RetCam wide-field infant fundus image · camera: Clarity RetCam 3 (130° FOV) · 640x480px:
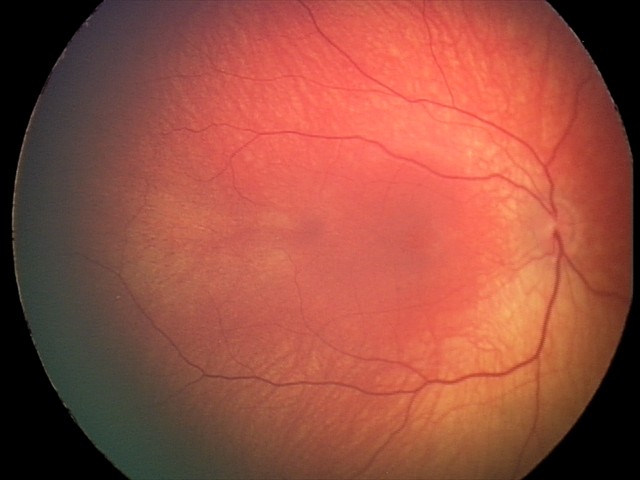
Q: What was the screening finding?
A: retinal hemorrhages